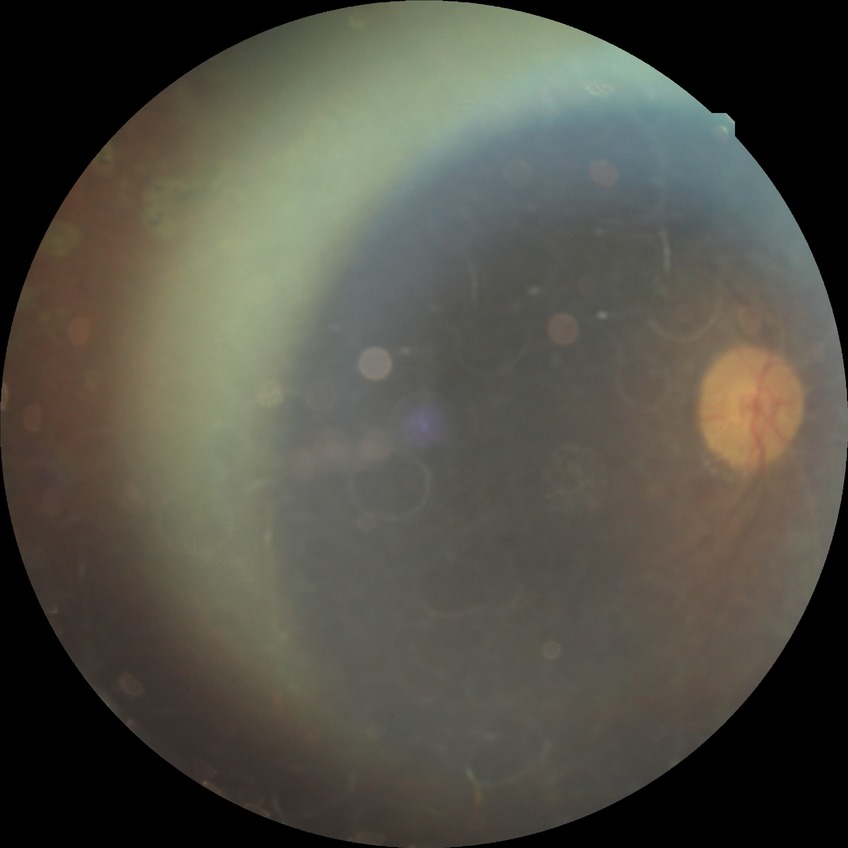
Diabetic retinopathy (DR) is proliferative diabetic retinopathy (PDR).